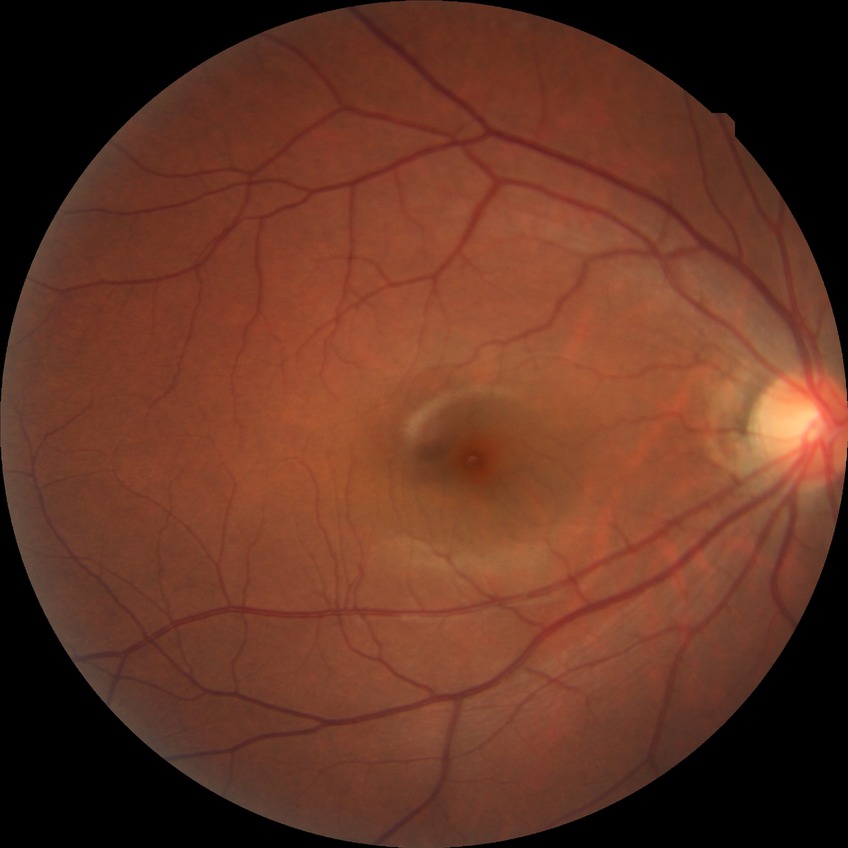 davis_grade: no diabetic retinopathy (NDR)